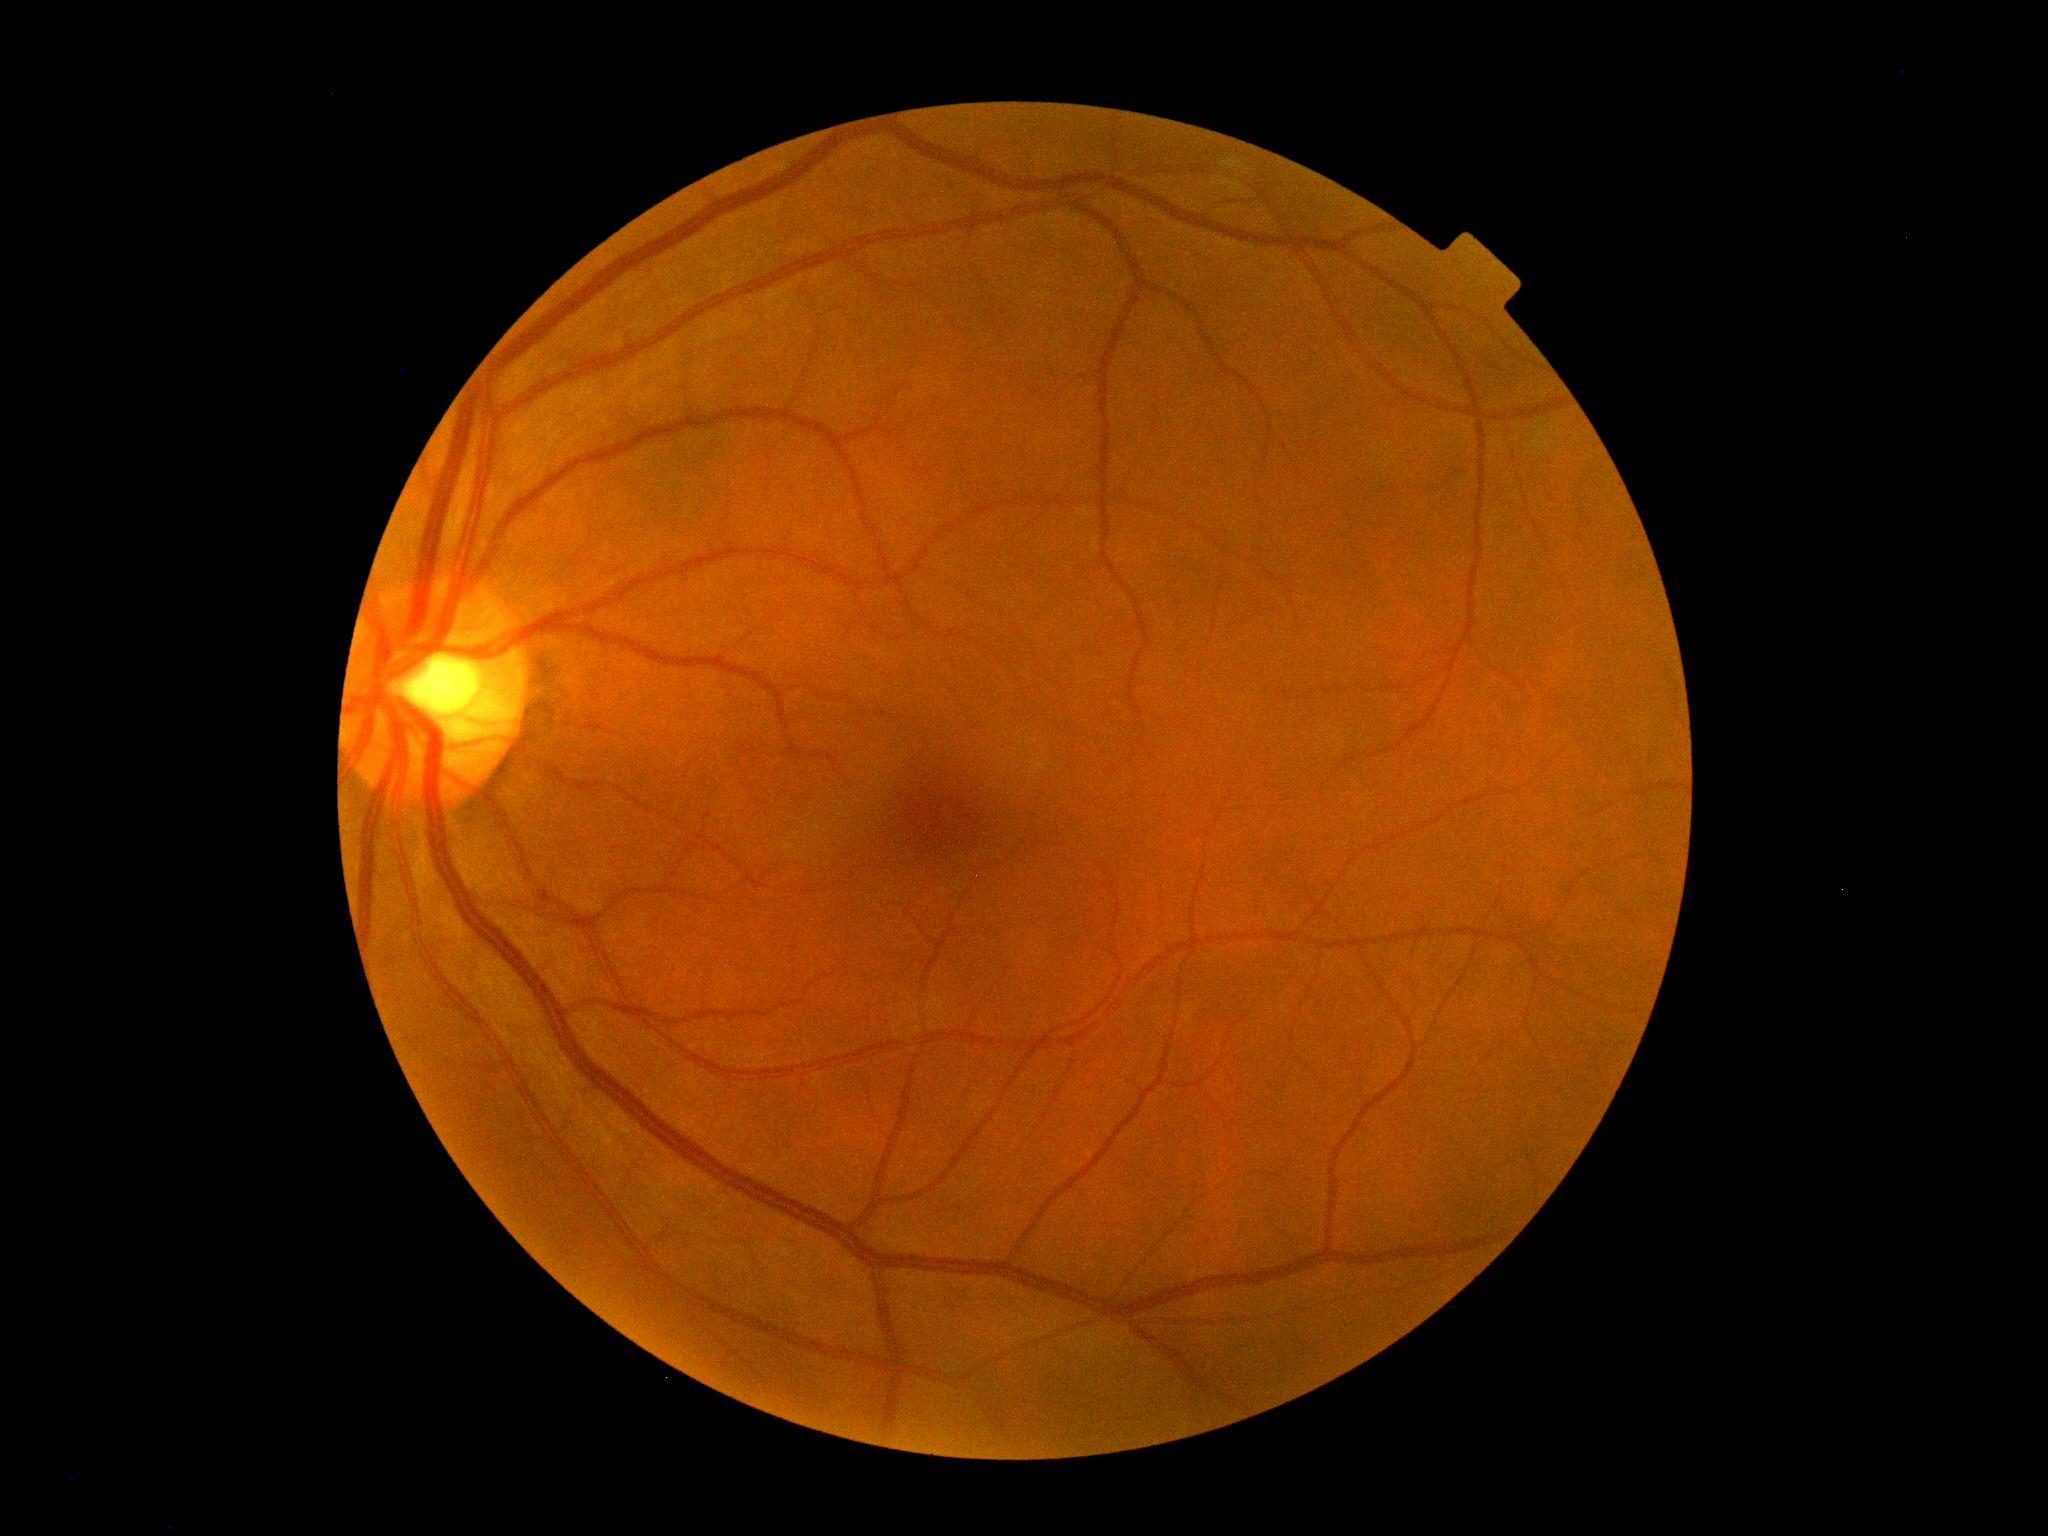
No diabetic retinal disease findings. Diabetic retinopathy grade is 0 — no visible signs of diabetic retinopathy.